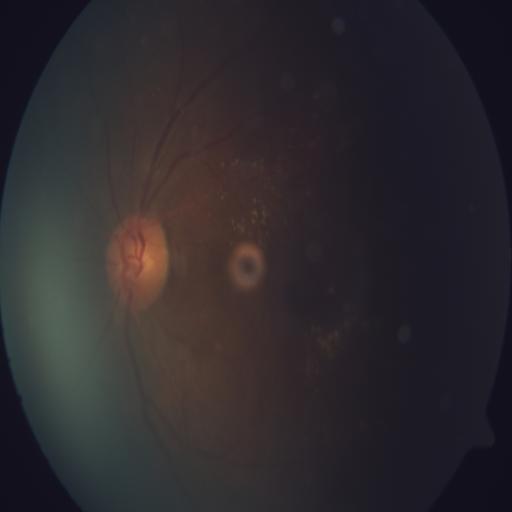 Fundus image with findings of drusen (DN).